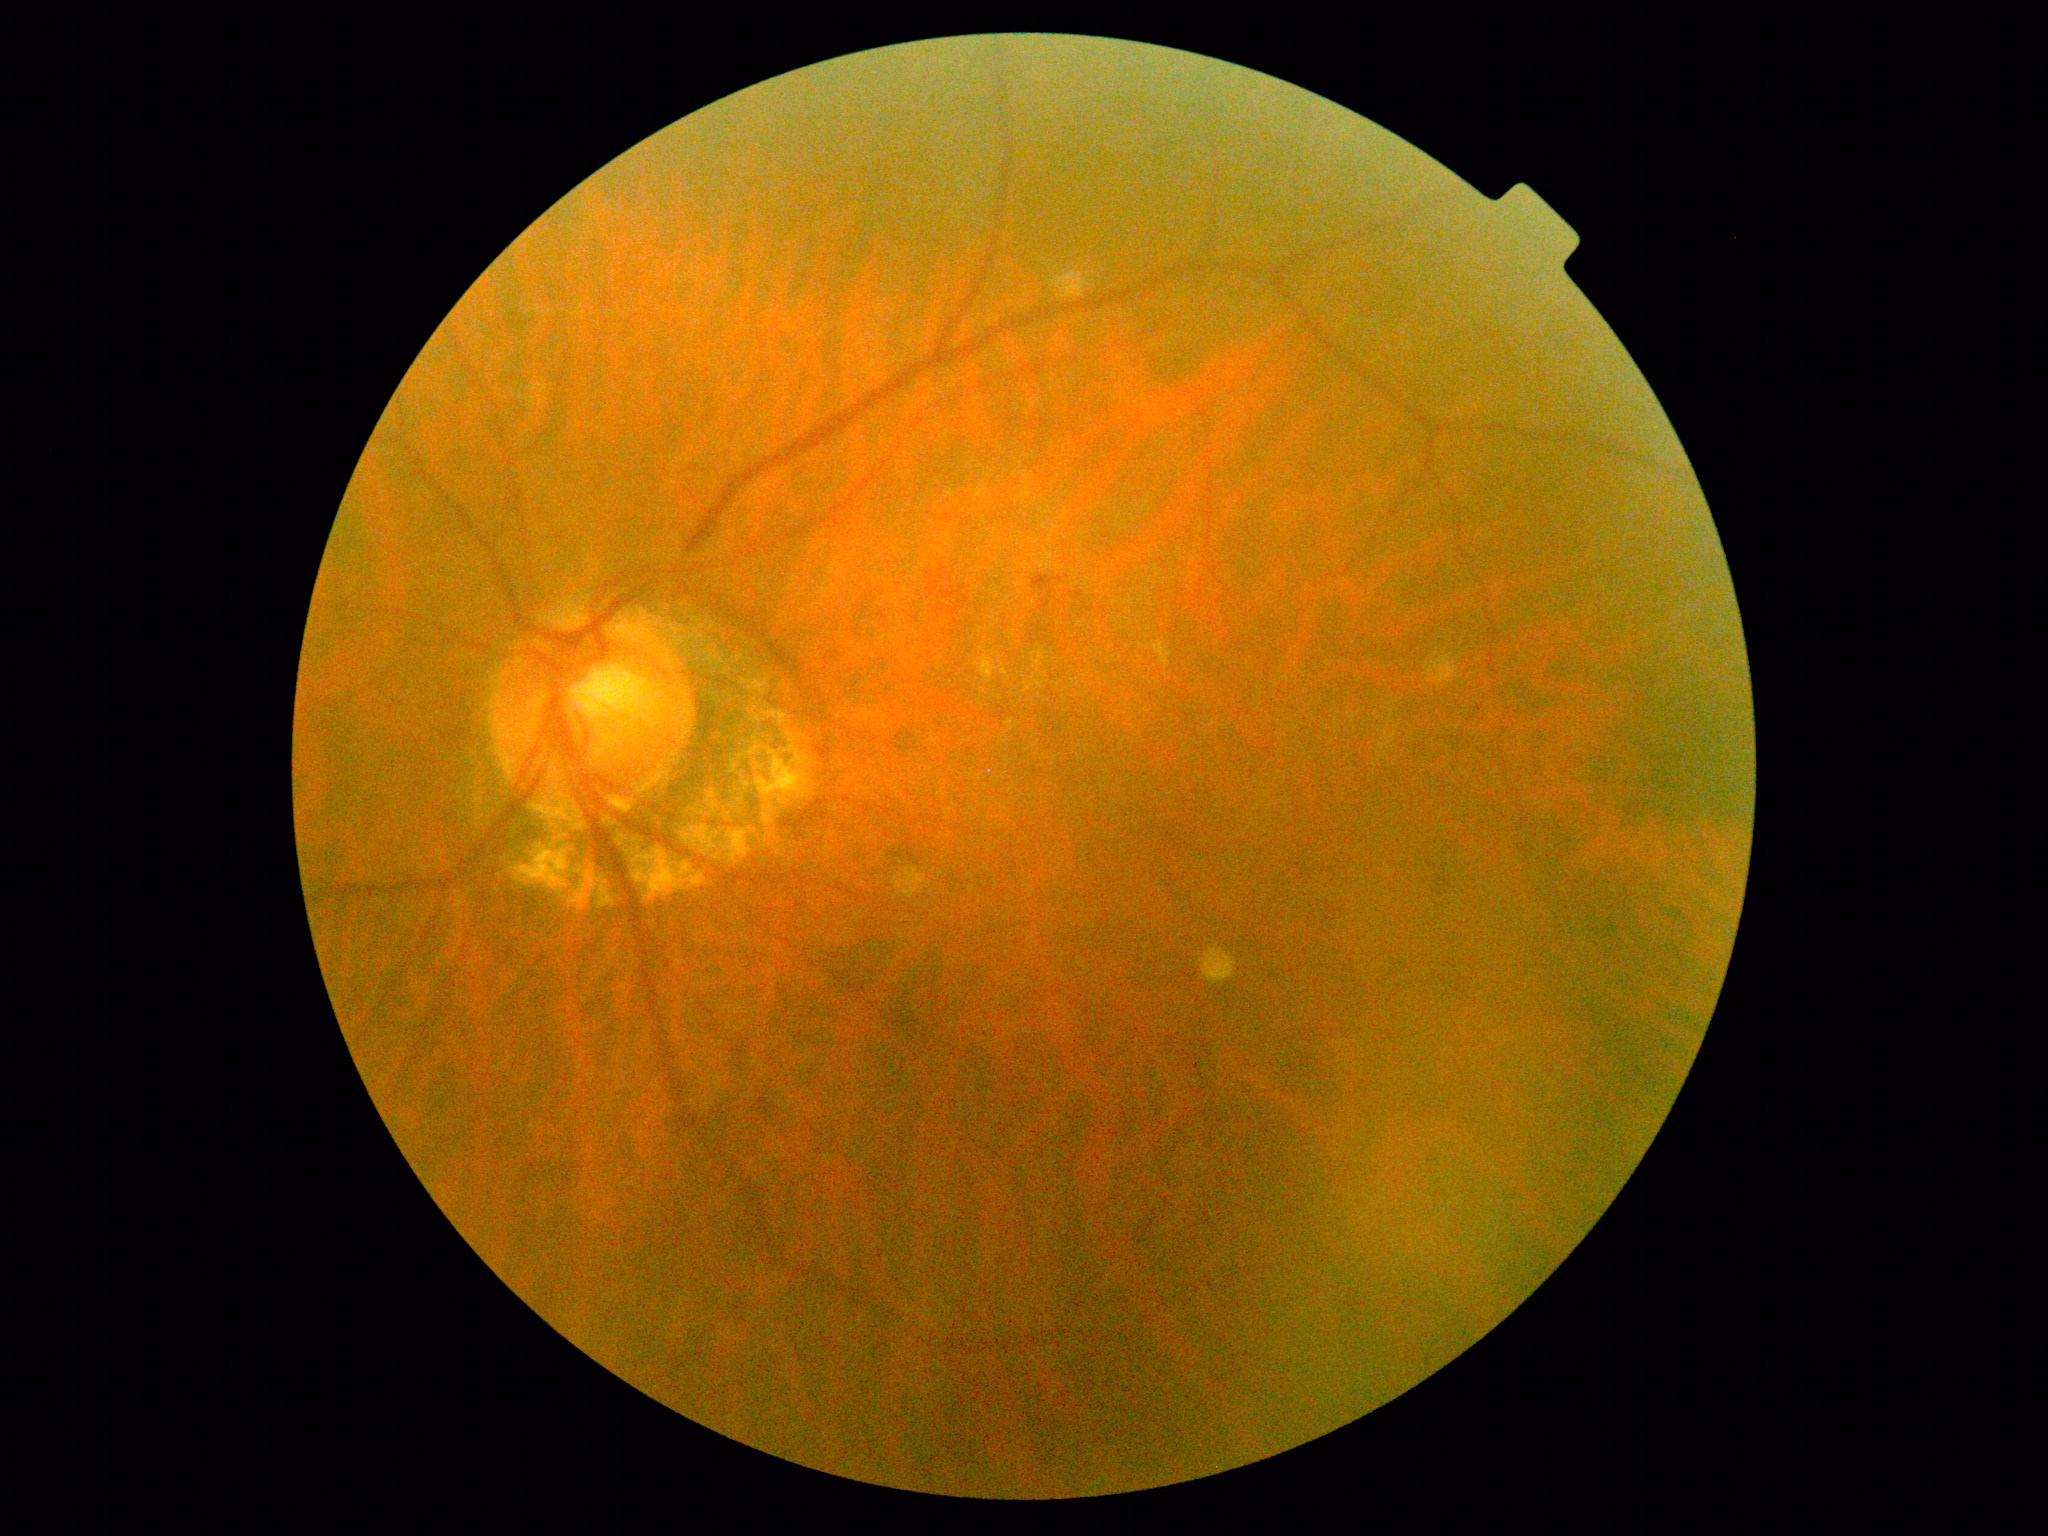
Diabetic retinopathy grade is moderate non-proliferative diabetic retinopathy (2) — more than just microaneurysms but less than severe NPDR. Disease class: non-proliferative diabetic retinopathy.